DR severity per modified Davis staging: 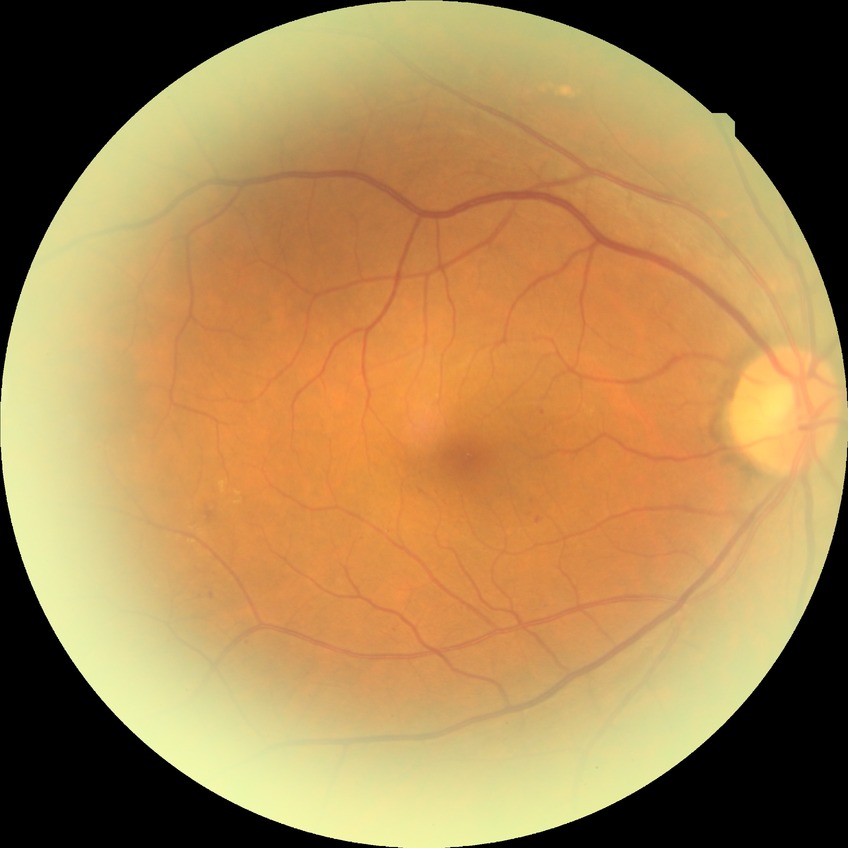

Disease class: non-proliferative diabetic retinopathy. Modified Davis grading is simple diabetic retinopathy.